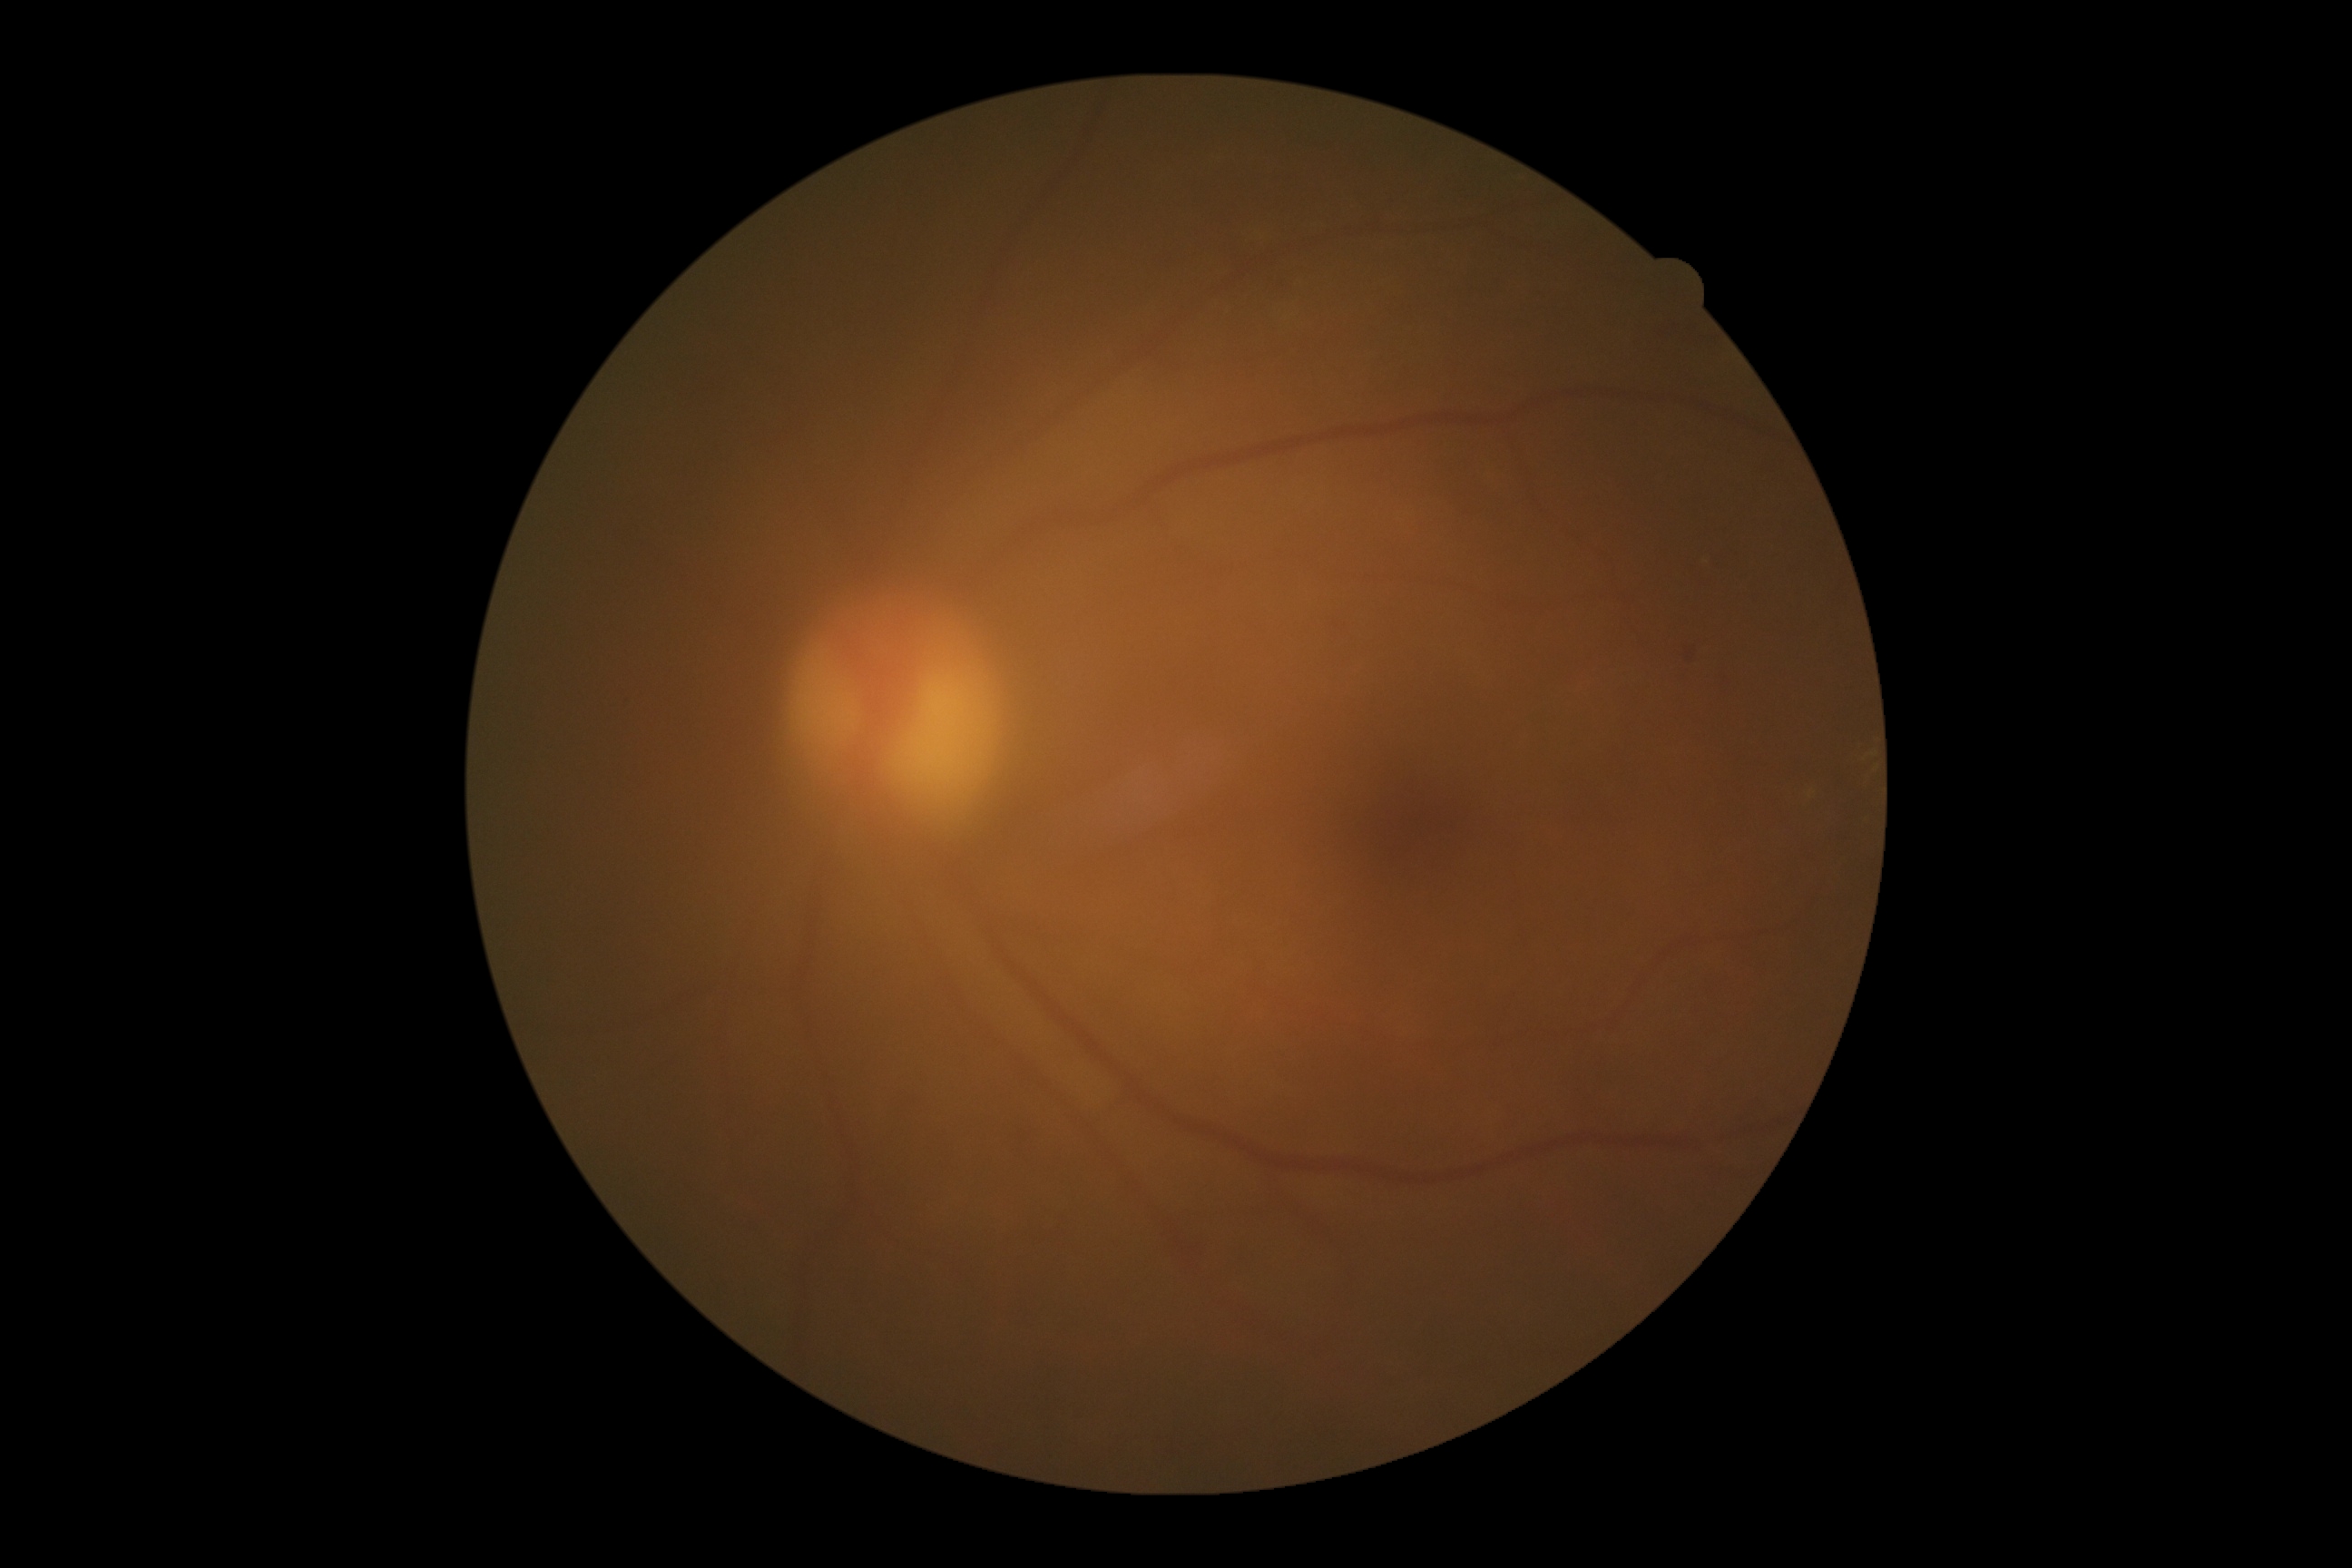
DR class = non-proliferative diabetic retinopathy
diabetic retinopathy grade = moderate non-proliferative diabetic retinopathy (2)